2352 by 1568 pixels
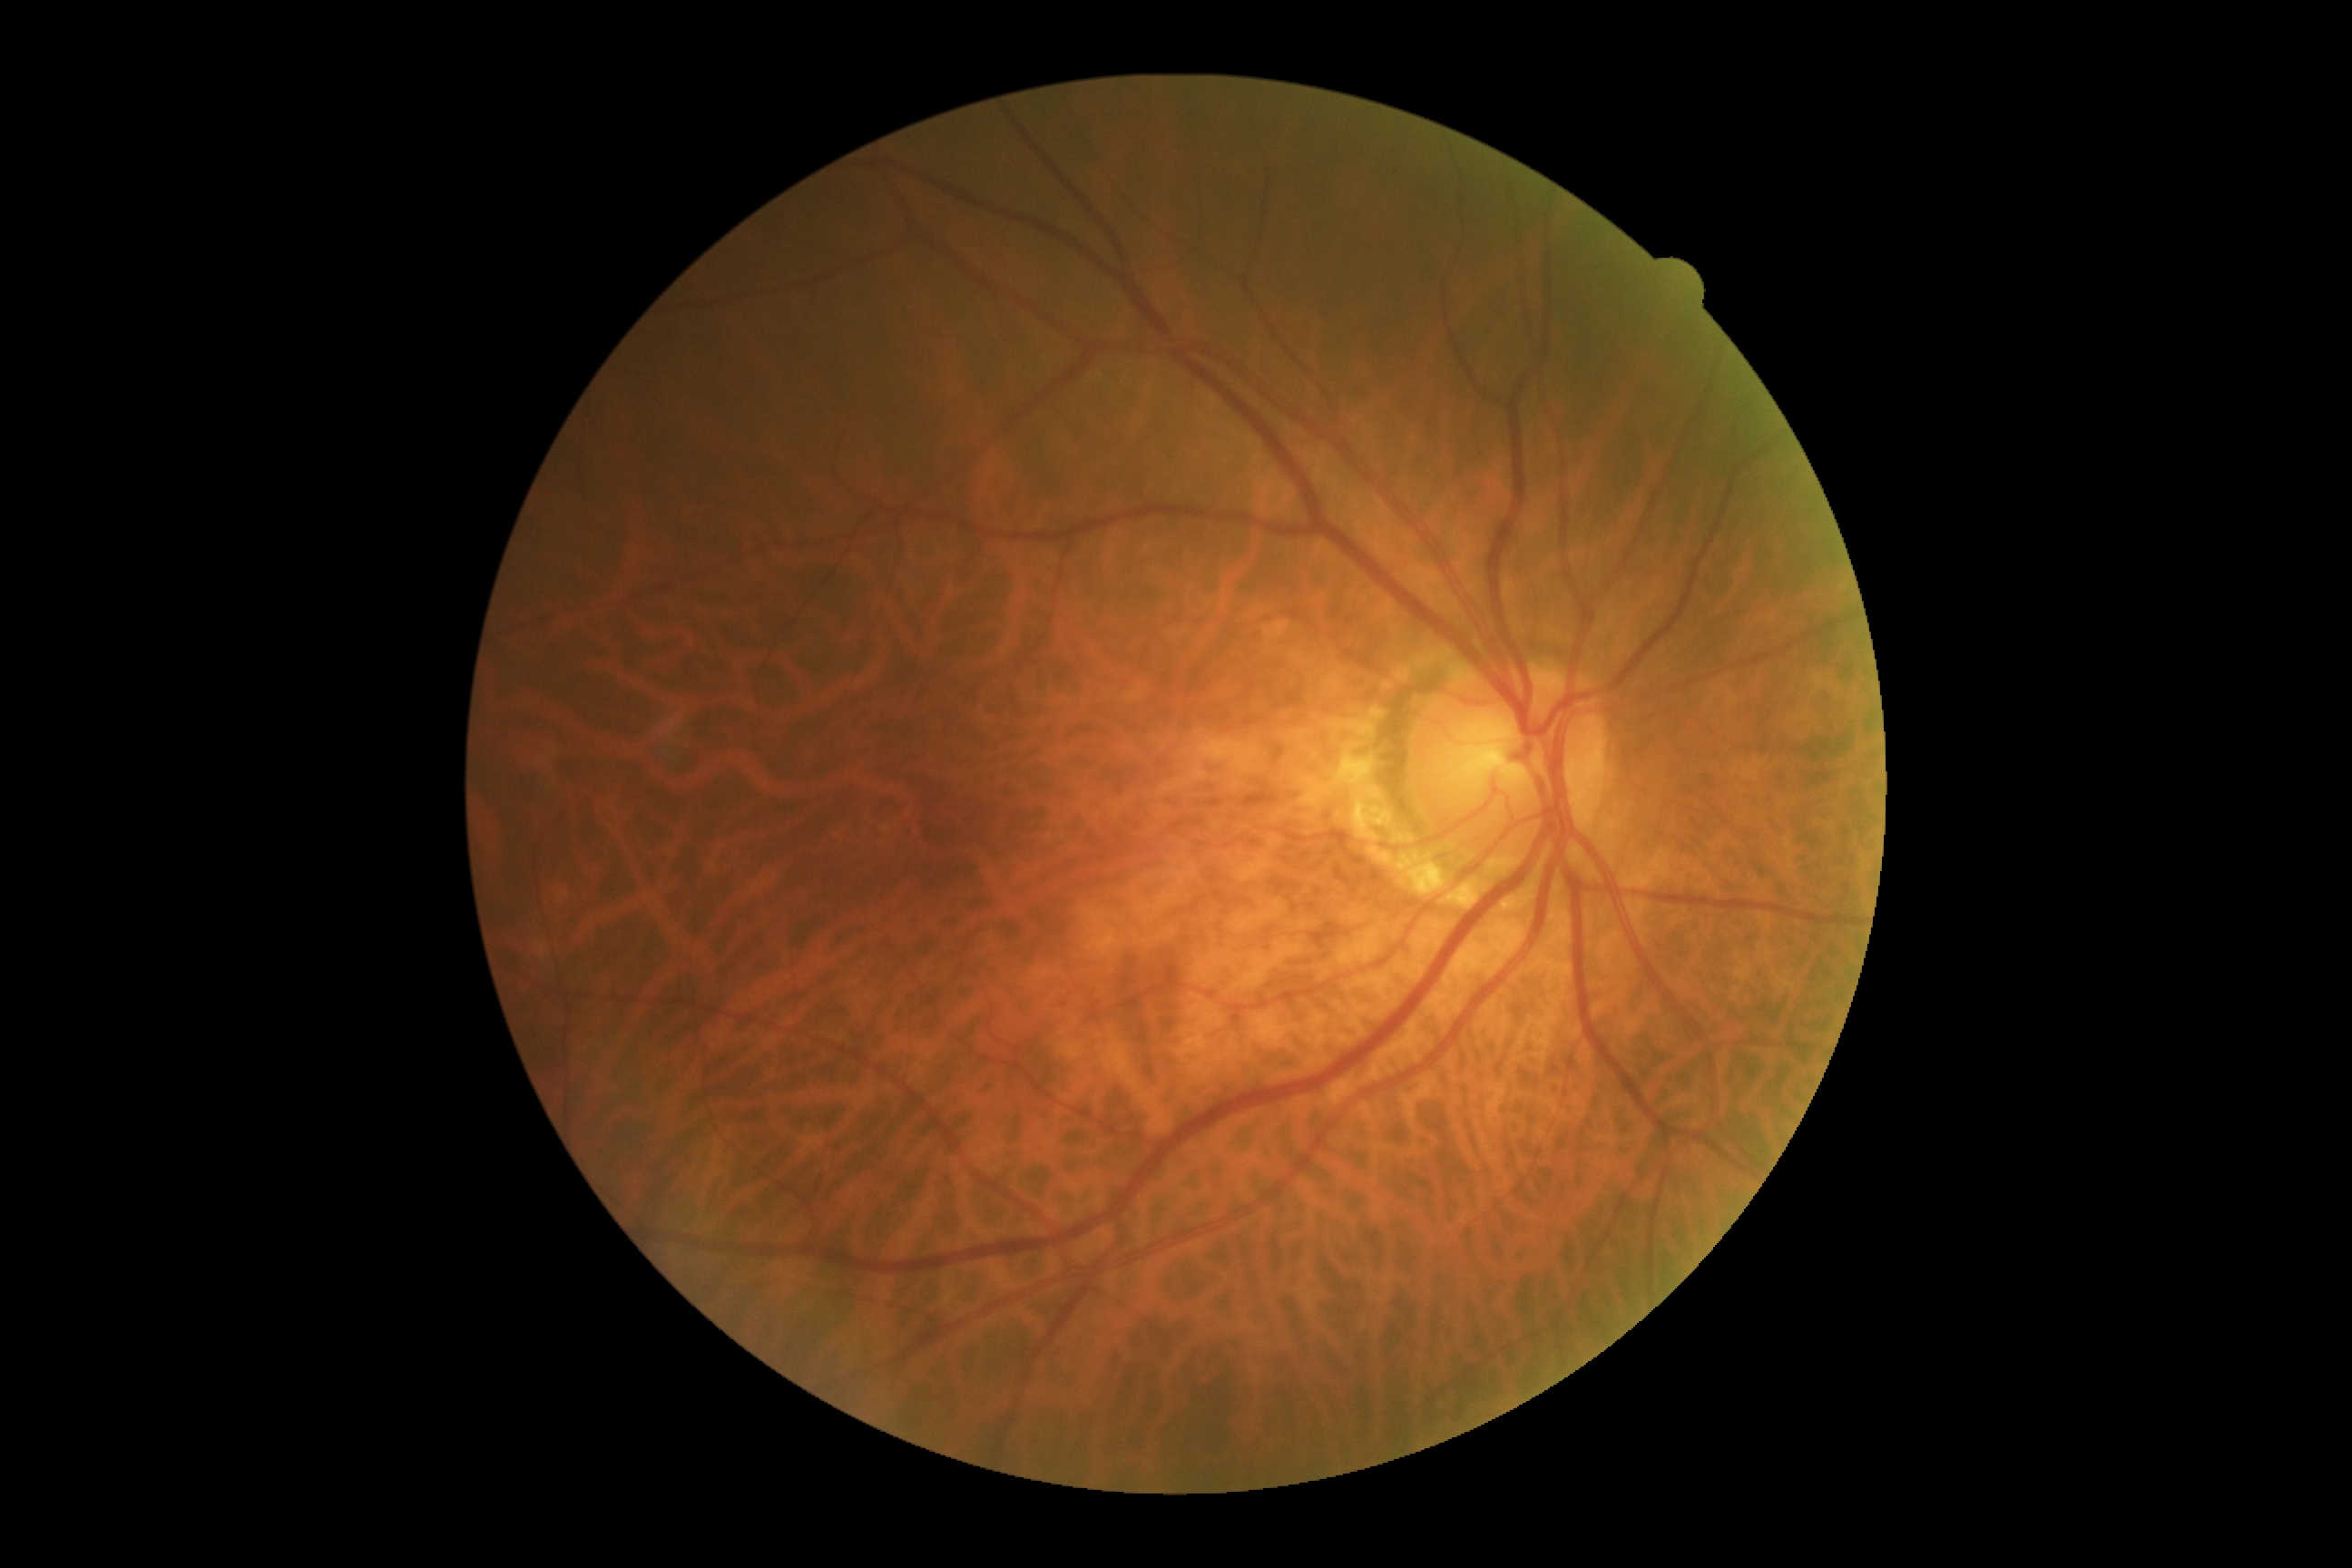
retinopathy = 0 — no visible signs of diabetic retinopathy
DR impression = no DR findings